1536 x 1152 pixels; FOV: 45 degrees: 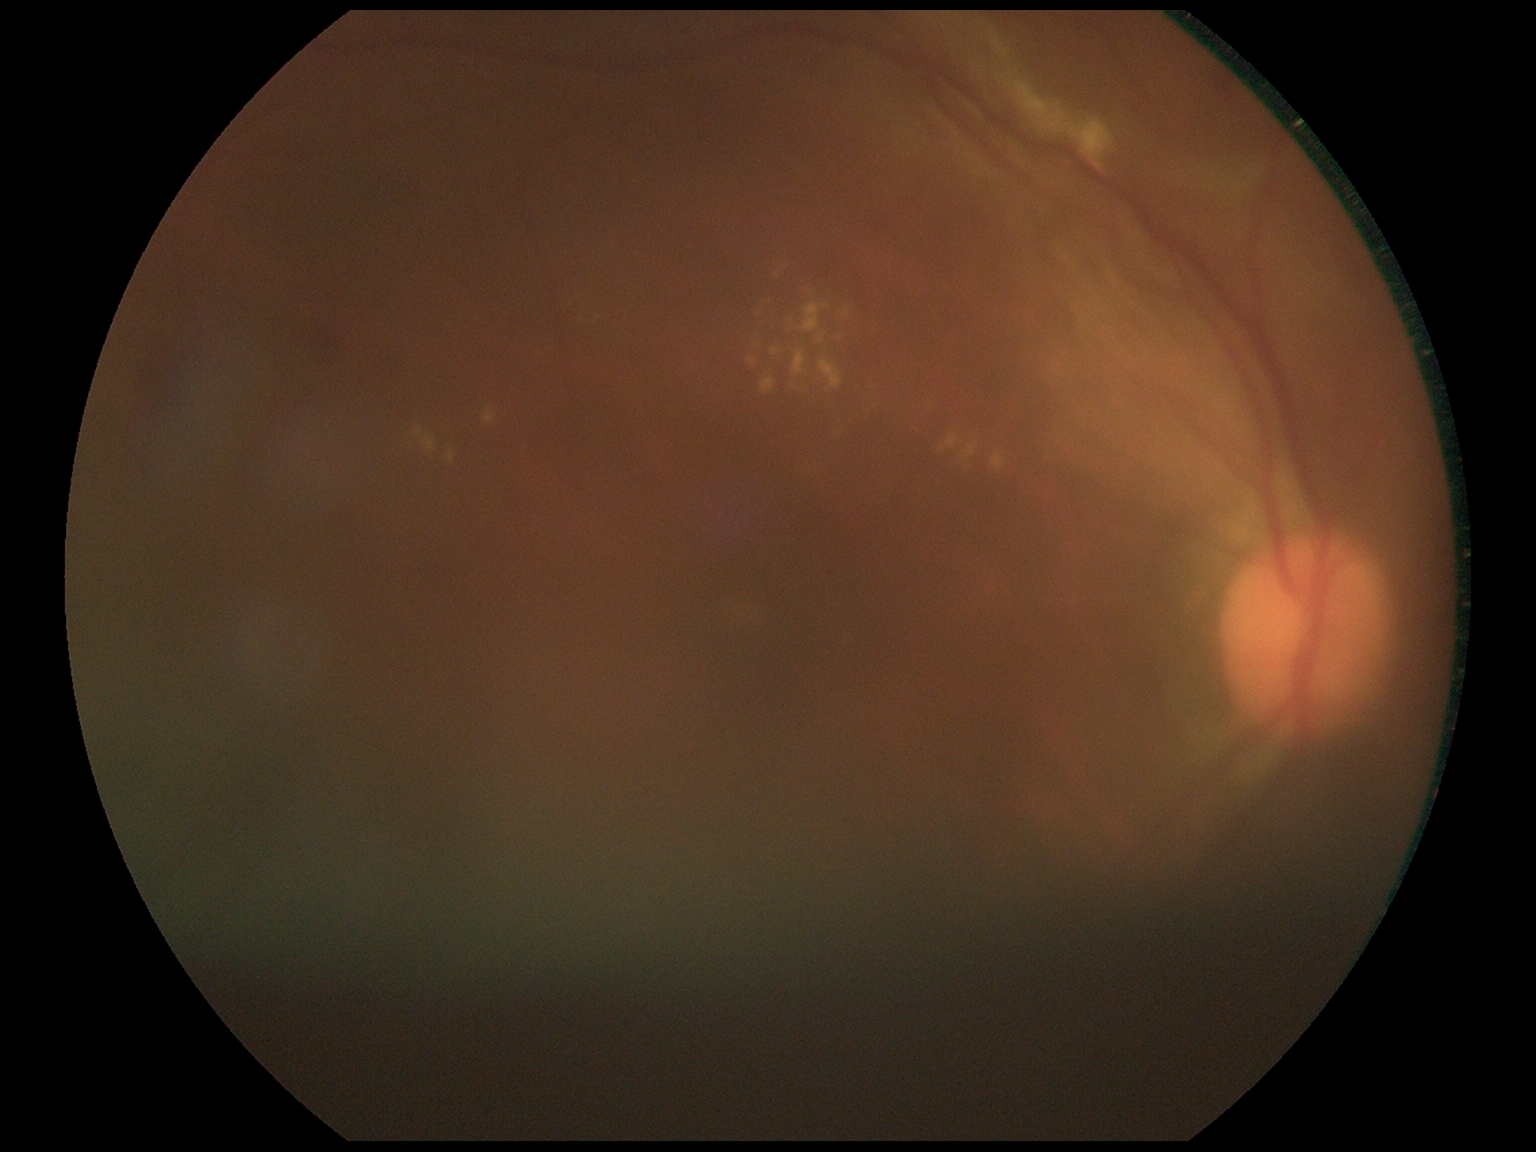
diabetic retinopathy (DR): moderate non-proliferative diabetic retinopathy (grade 2); DR class: non-proliferative diabetic retinopathy.